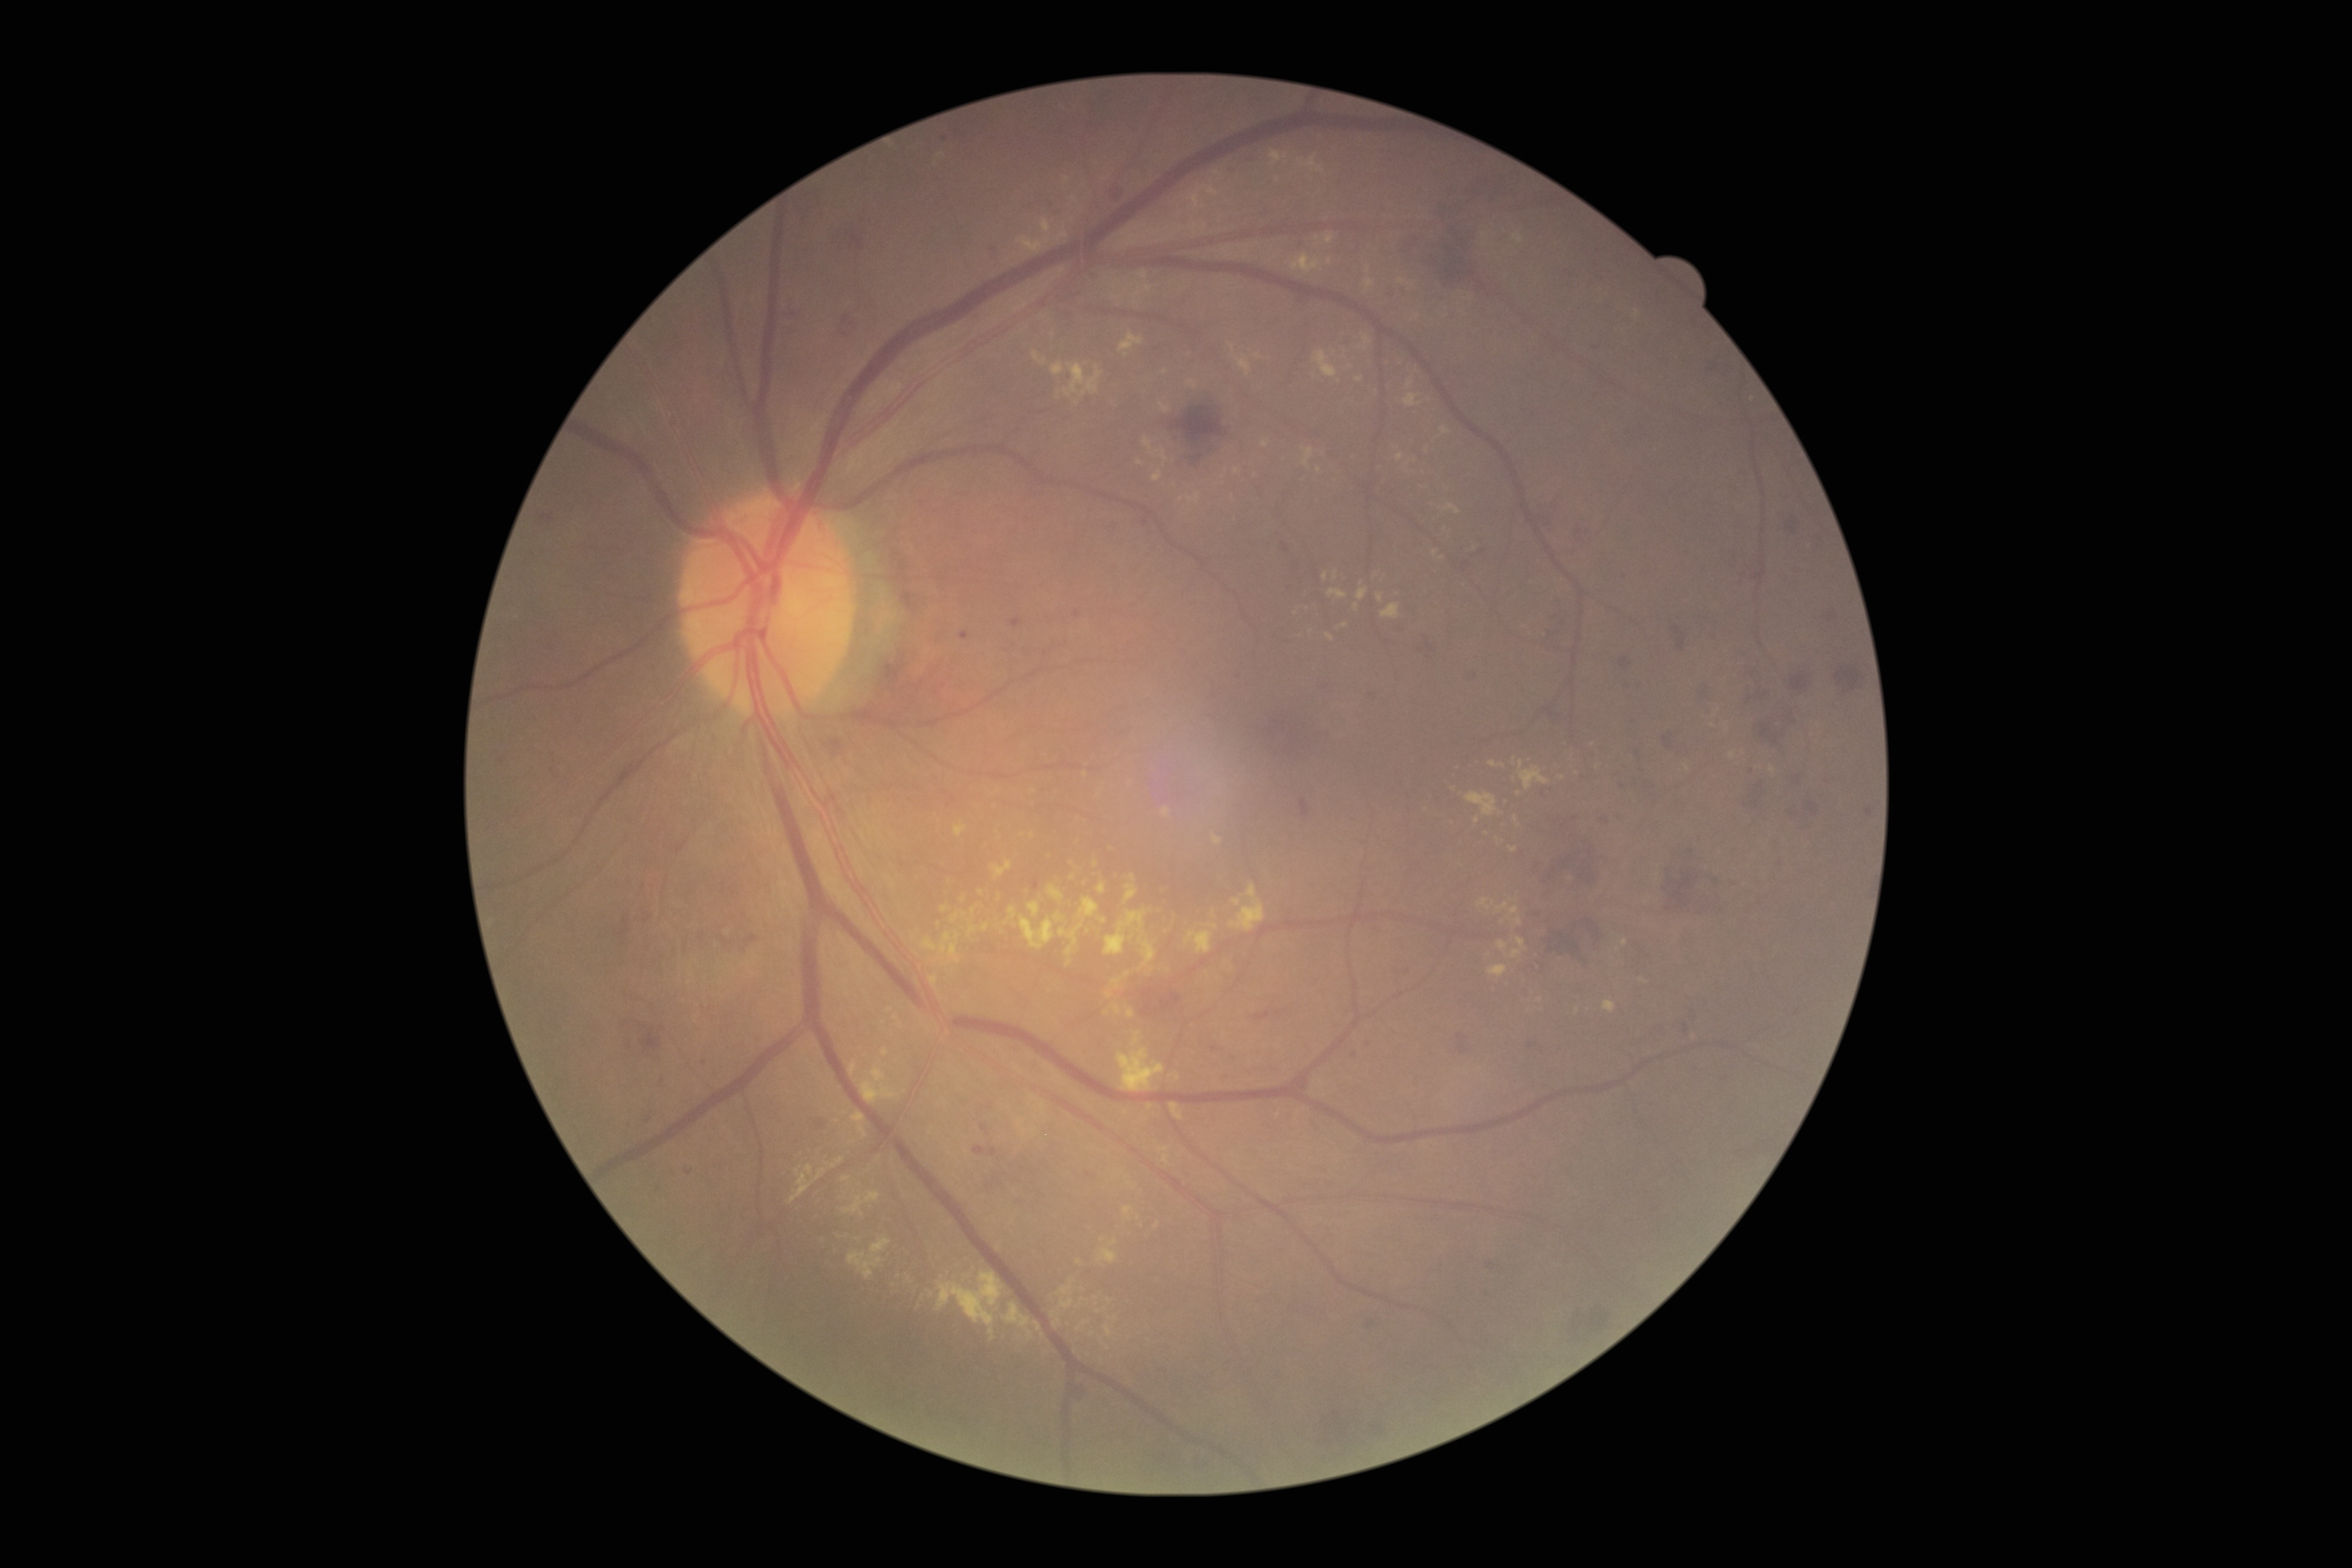

Retinopathy grade: 2/4
Representative lesions:
microaneurysms (more not shown): box(1075, 610, 1080, 618) | box(1011, 619, 1022, 629) | box(685, 1169, 693, 1174) | box(1034, 880, 1040, 890) | box(981, 1125, 989, 1134) | box(960, 630, 969, 639)
Microaneurysms (small, approximate centers) near (x=1759, y=786) | (x=1355, y=1055) | (x=1407, y=971) | (x=1088, y=1174) | (x=1752, y=771) | (x=945, y=139) | (x=1491, y=1266) | (x=1215, y=1049)
soft exudates: not present
hemorrhages (more not shown): box(1373, 1425, 1382, 1431) | box(1397, 229, 1480, 292) | box(989, 246, 999, 258) | box(1590, 1307, 1611, 1331) | box(1466, 673, 1479, 683) | box(816, 1120, 825, 1128) | box(621, 919, 631, 935) | box(1835, 666, 1865, 691) | box(1544, 921, 1593, 969) | box(1686, 844, 1700, 854) | box(741, 935, 758, 950) | box(1636, 743, 1644, 773) | box(854, 222, 867, 250) | box(1391, 622, 1405, 635) | box(1788, 806, 1795, 820) | box(1642, 779, 1661, 792) | box(1690, 1004, 1698, 1023)
hard exudates (more not shown): box(1327, 635, 1335, 641) | box(1098, 1248, 1117, 1264) | box(1292, 255, 1321, 275) | box(1004, 1302, 1034, 1340) | box(1171, 1103, 1183, 1120) | box(1354, 603, 1359, 612) | box(850, 1062, 857, 1075) | box(1489, 760, 1506, 768) | box(937, 1271, 1004, 1340) | box(1127, 1008, 1135, 1018) | box(1053, 1319, 1062, 1327) | box(1364, 278, 1375, 292)
Hard exudates (small, approximate centers) near (x=1577, y=772) | (x=1311, y=632) | (x=1095, y=864) | (x=998, y=1308) | (x=1126, y=1112) | (x=940, y=155) | (x=1181, y=499)